Wide-field contact fundus photograph of an infant · image size 640x480.
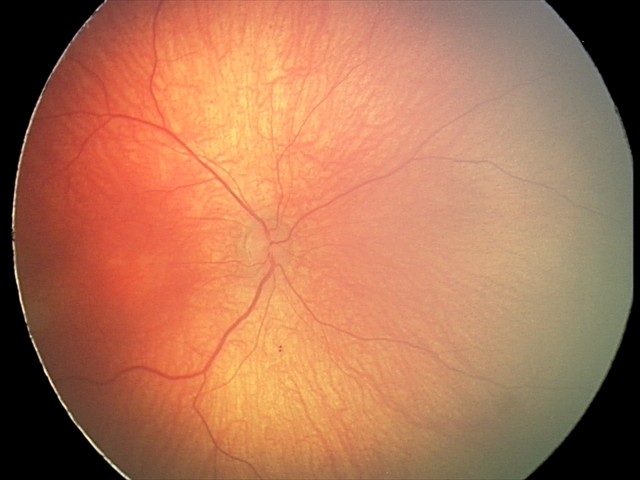
Q: What was the screening finding?
A: physiological appearance with no retinal pathology